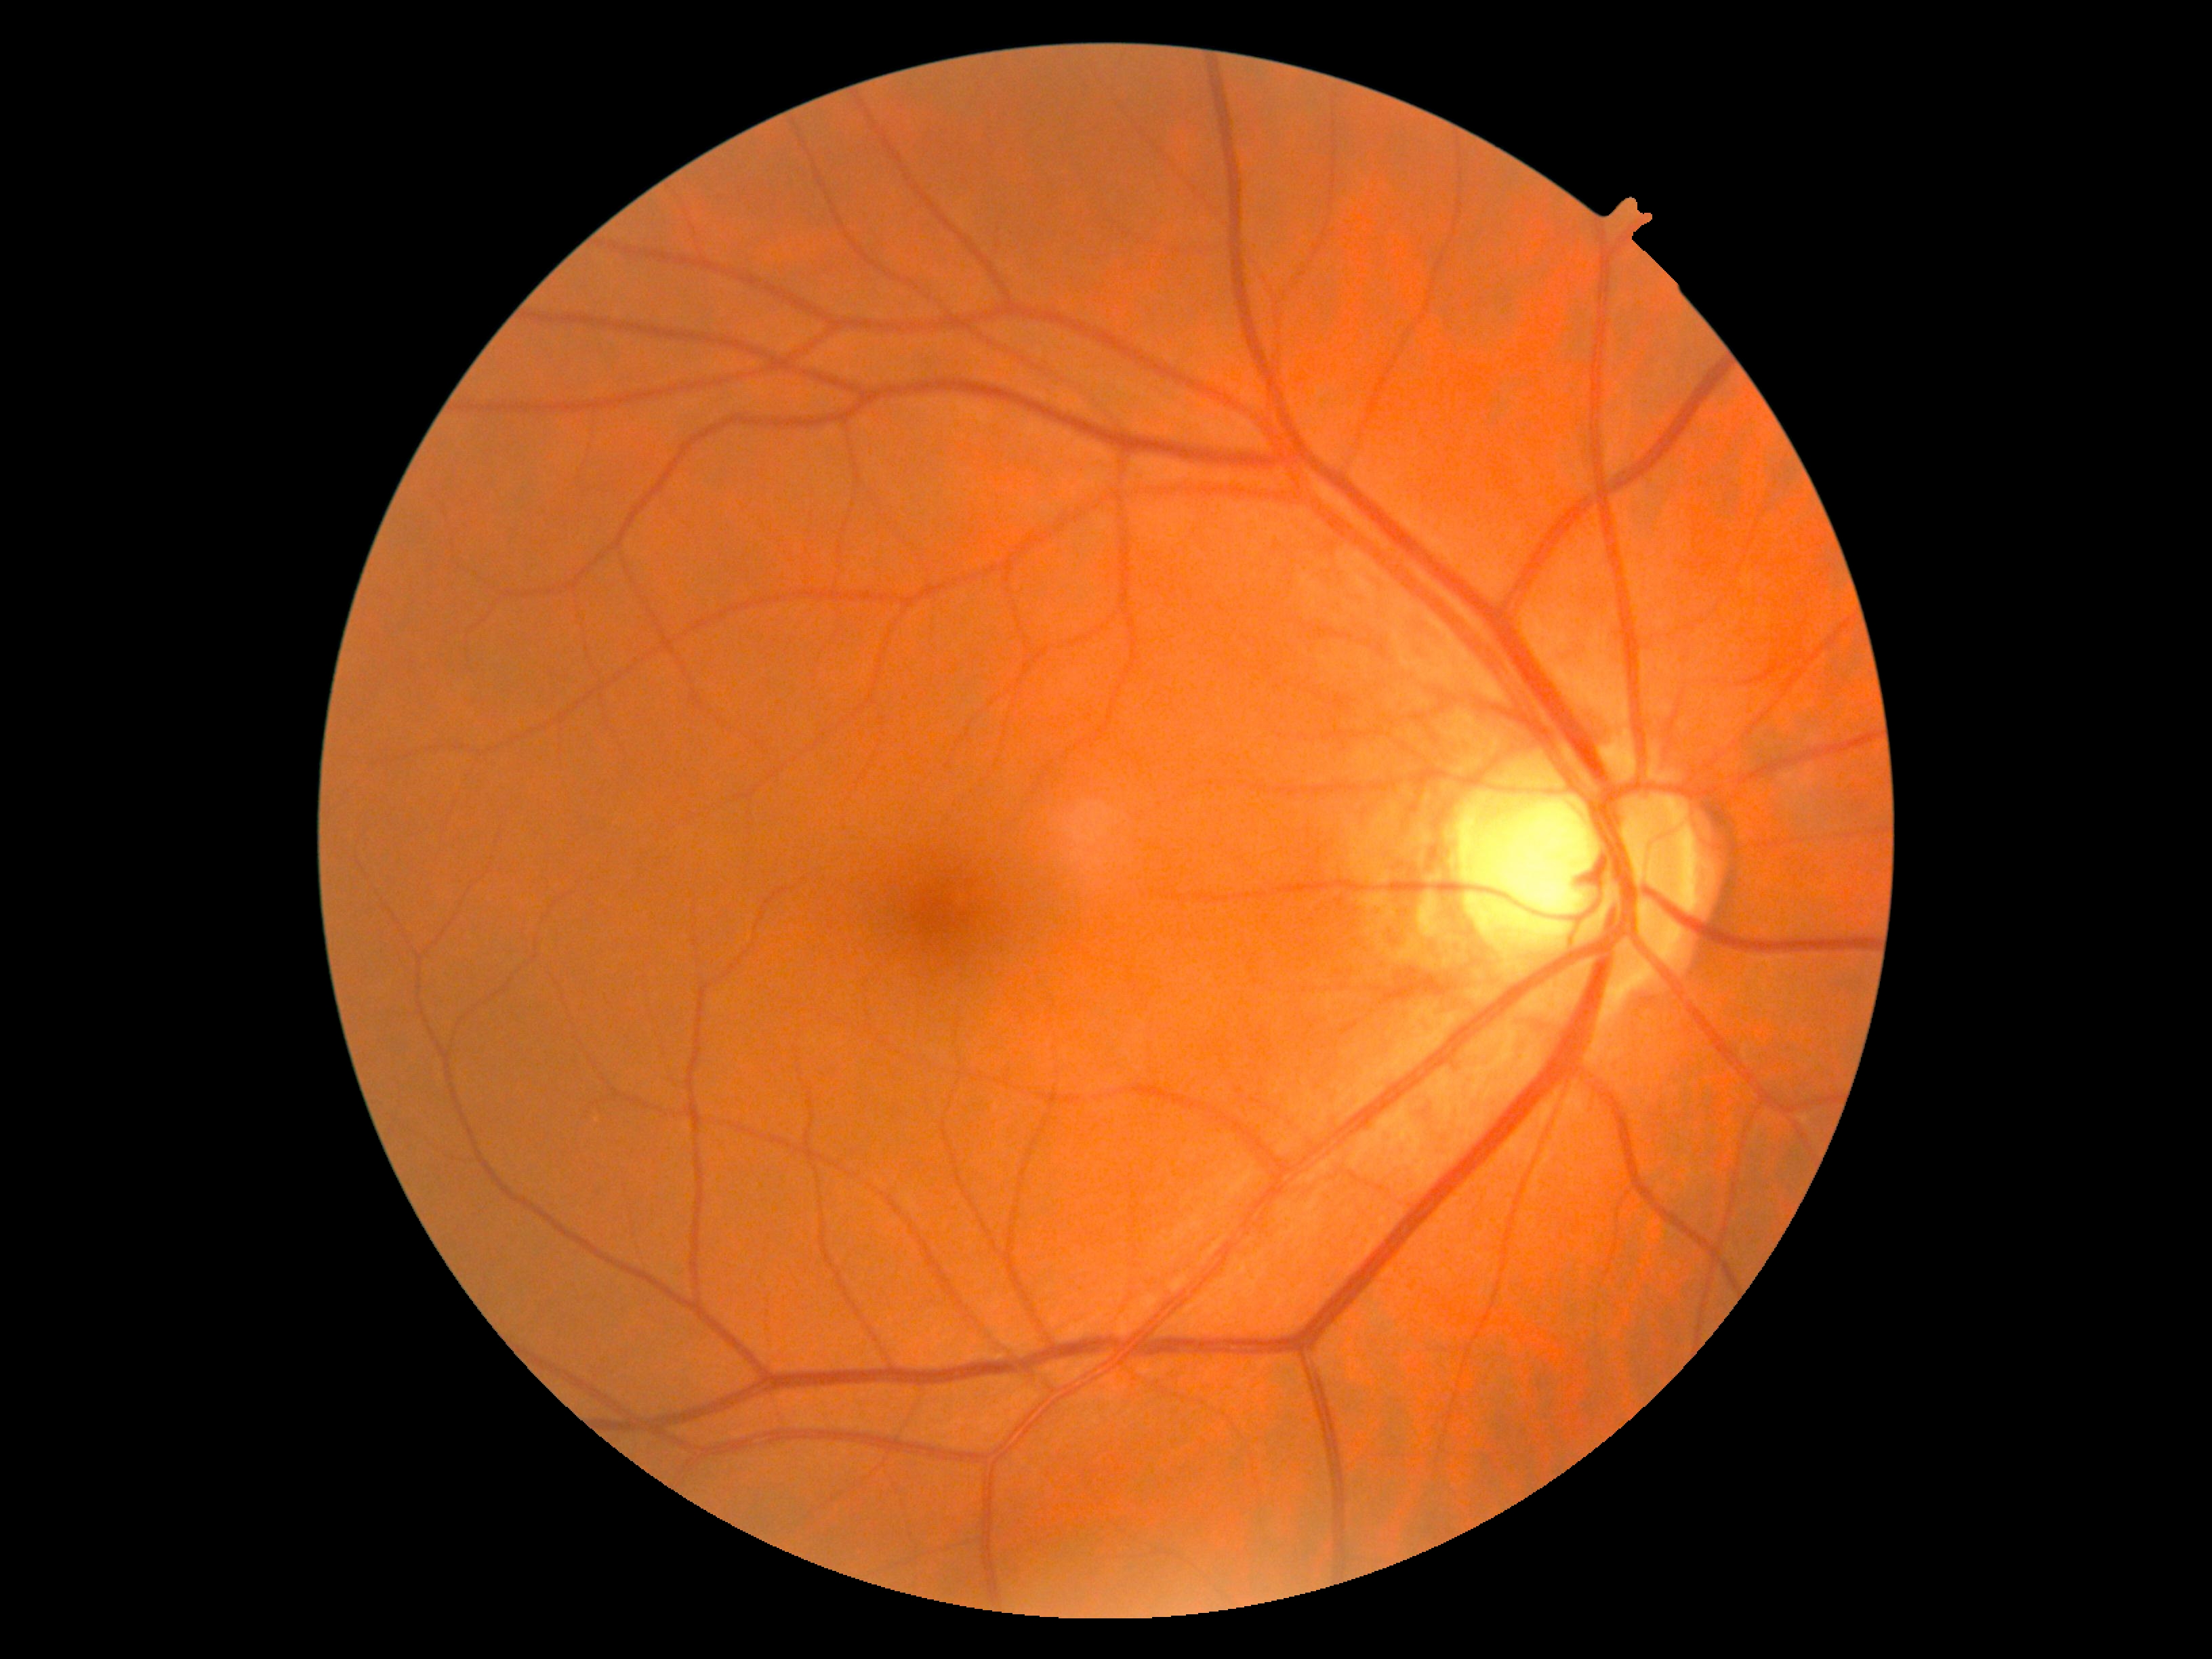

DR: 0/4.